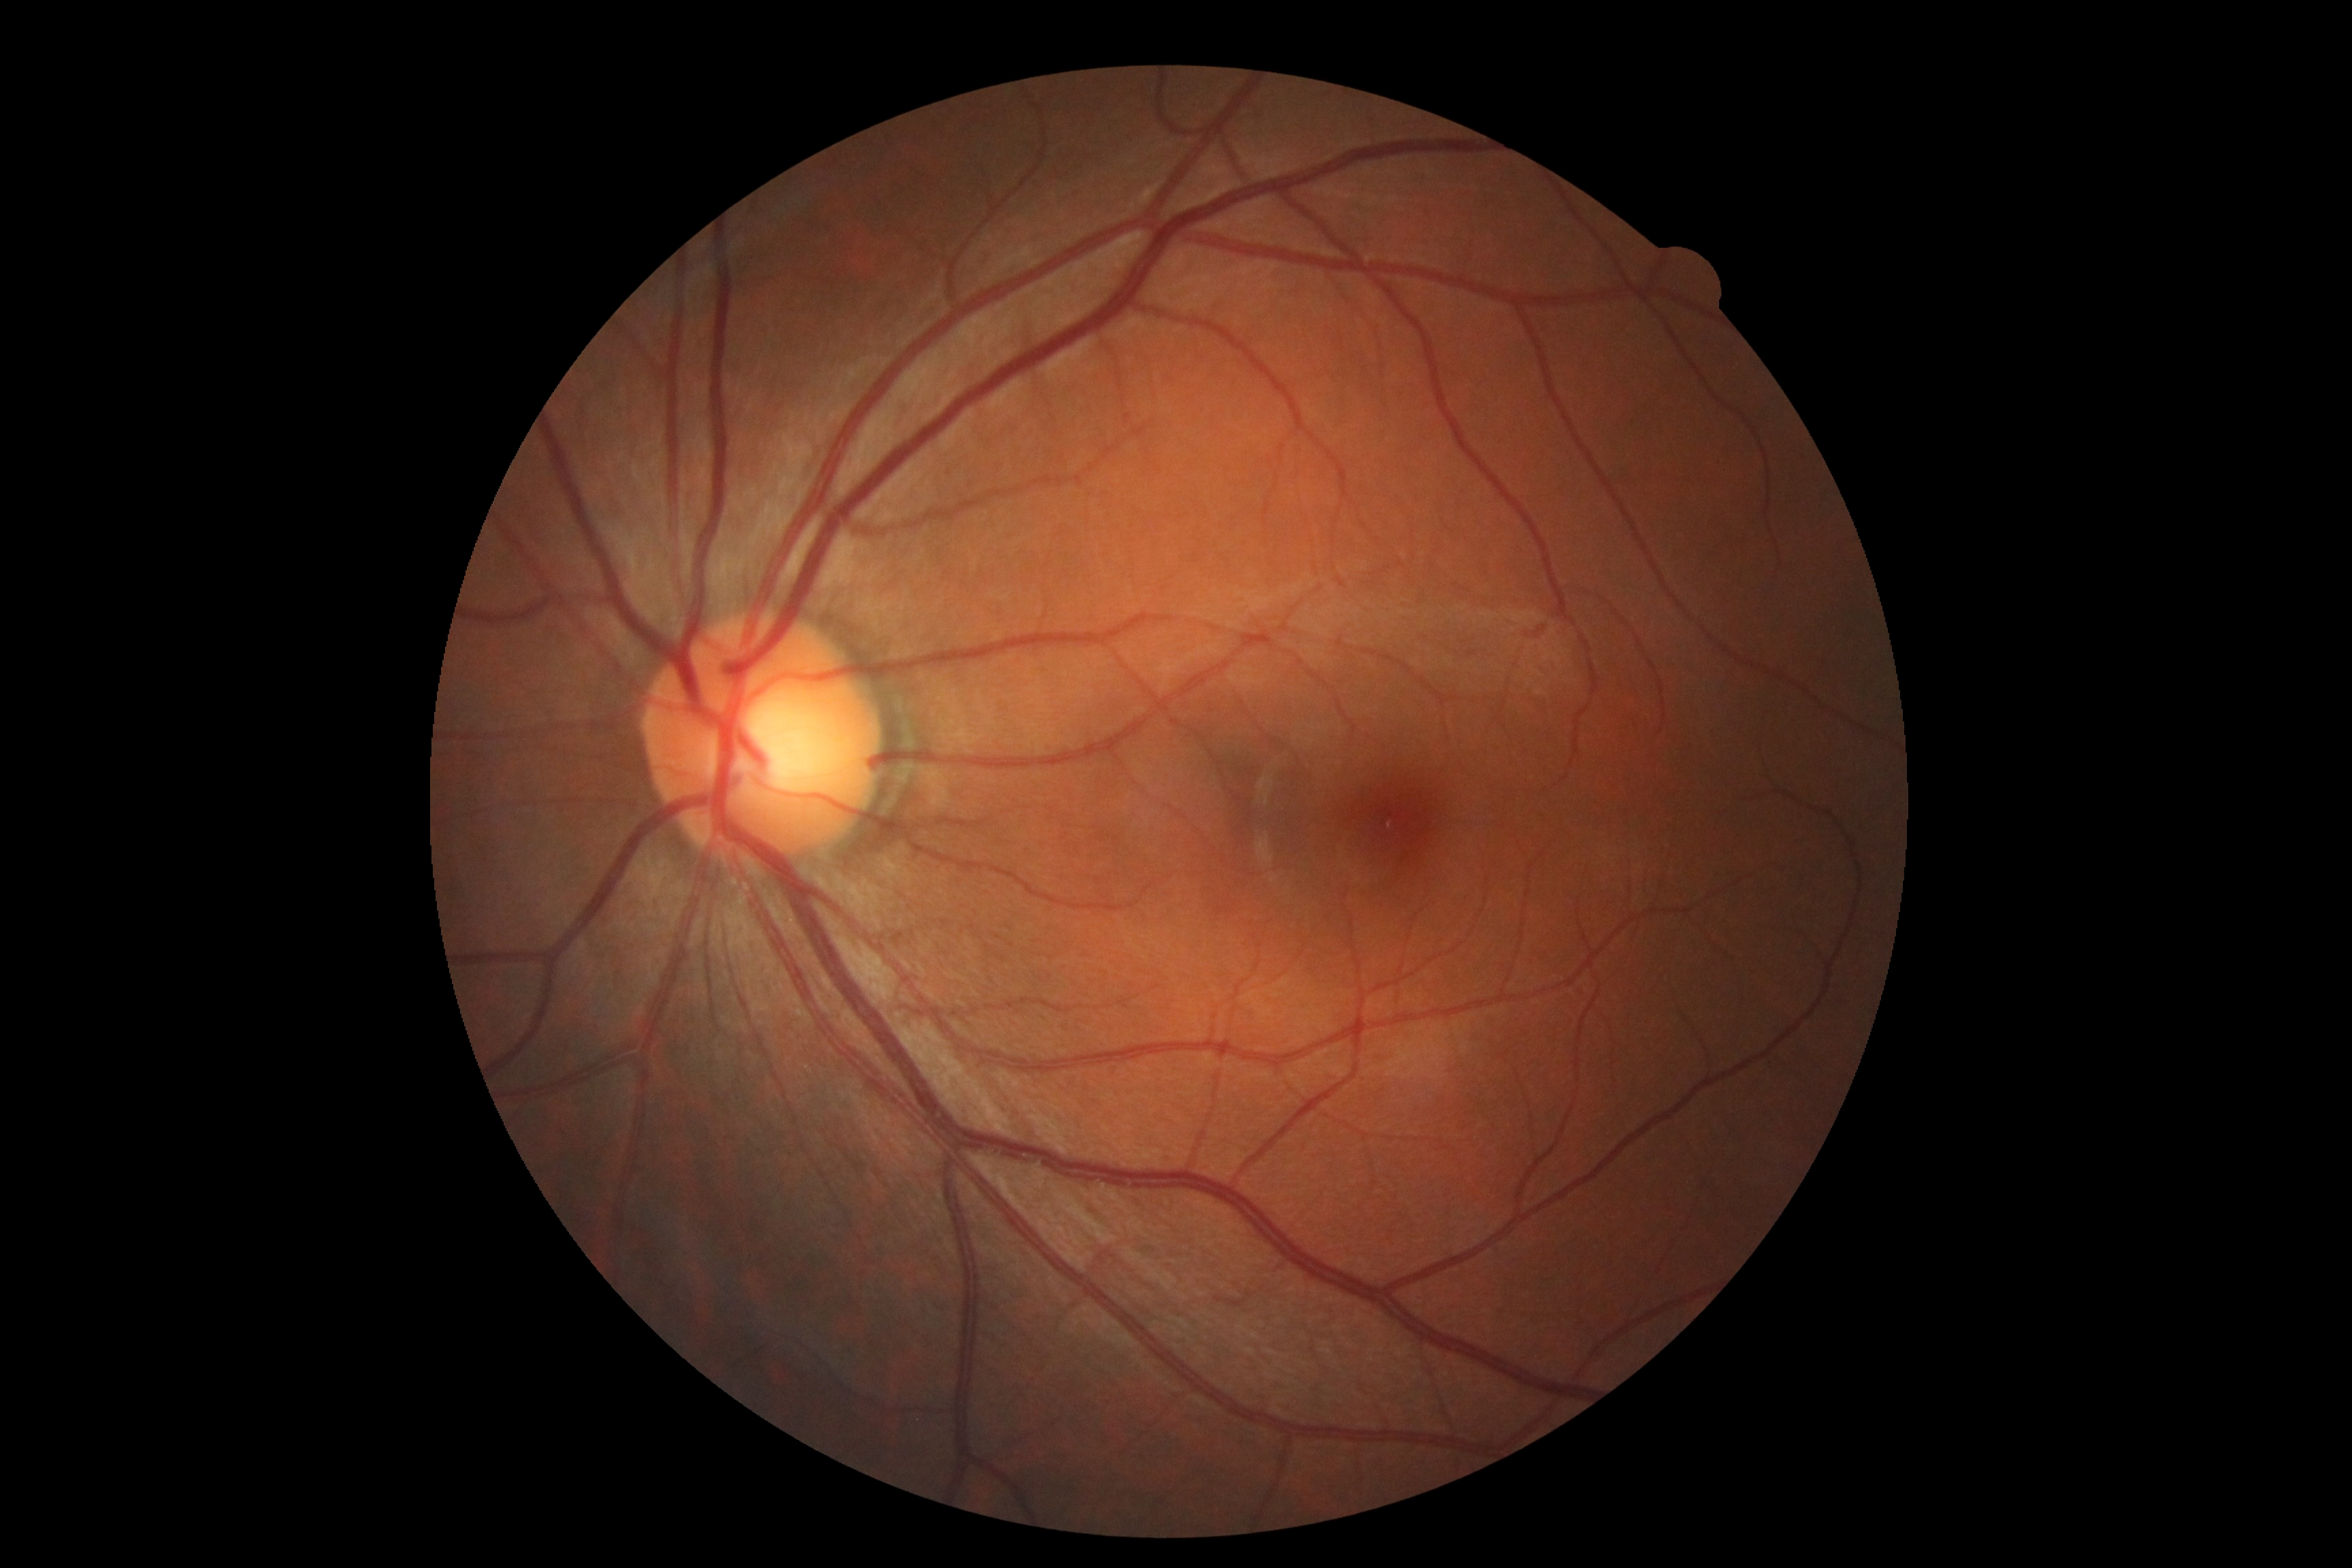 Retinopathy grade is no apparent retinopathy (0).
No diabetic retinal disease findings.